412x310px; FOV: 45 degrees; fundus photo: 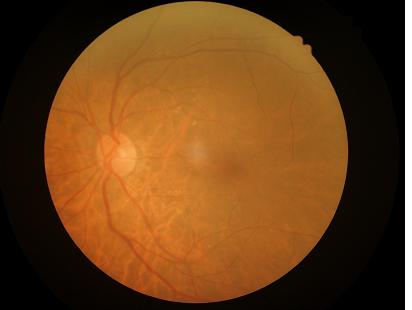

Acceptable image quality. The image is blurry. Good dynamic range. Even illumination with no color cast.